Acquired on the Natus RetCam Envision · infant wide-field fundus photograph · 1440x1080px.
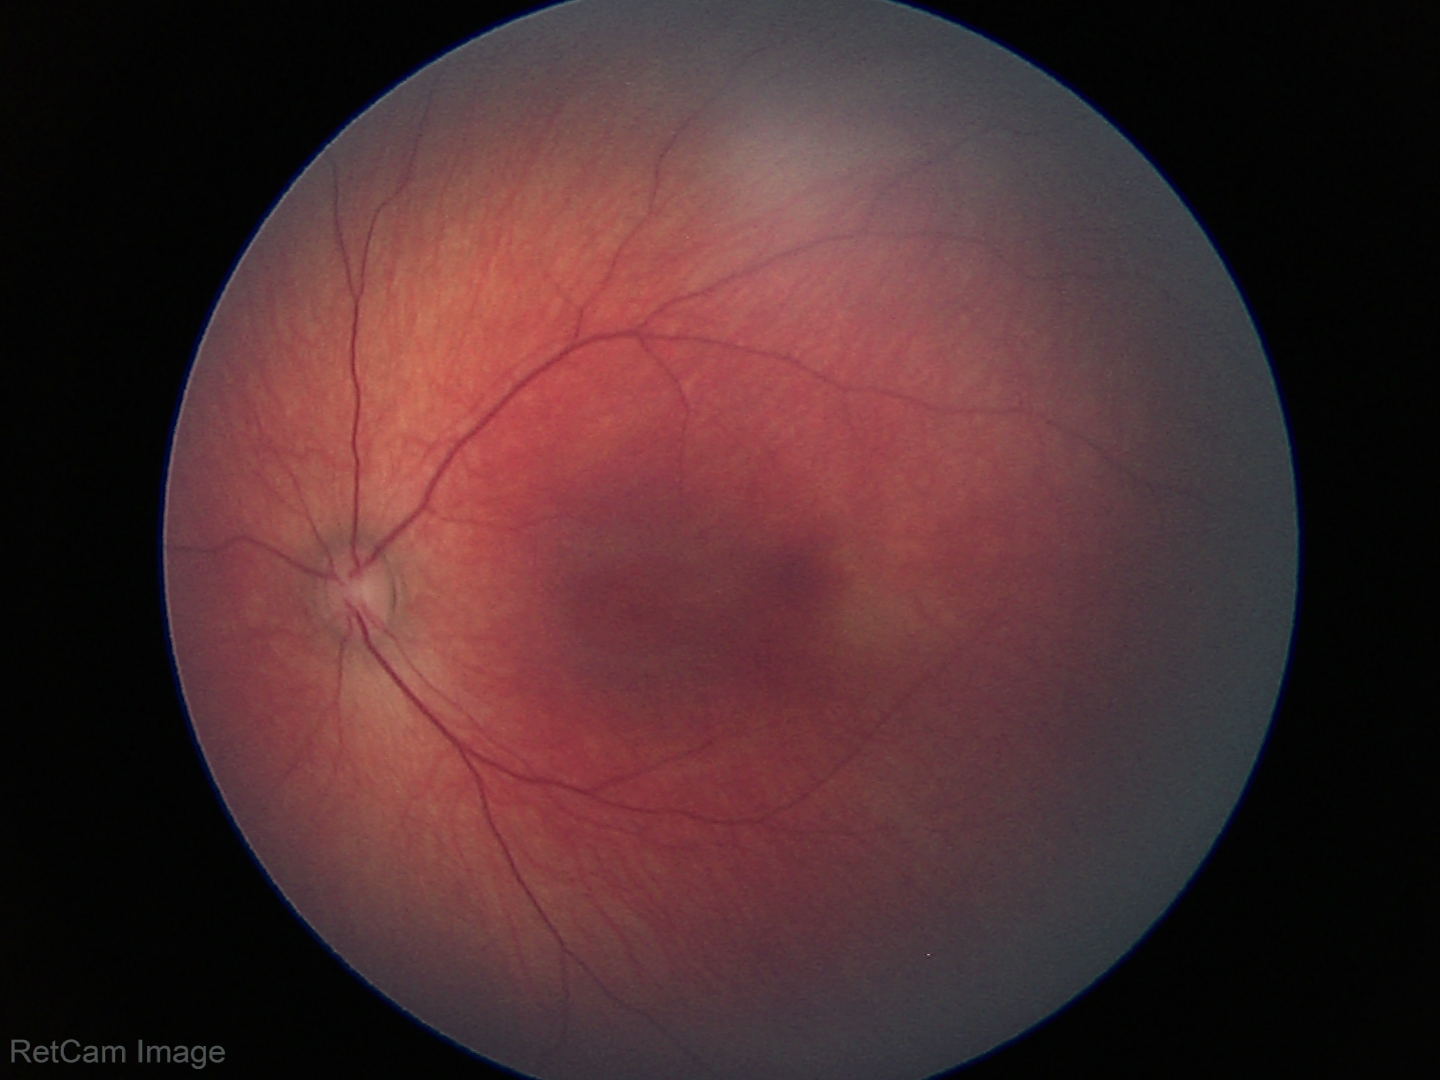
Screening diagnosis: physiological finding.